Color fundus image; Davis DR grading: 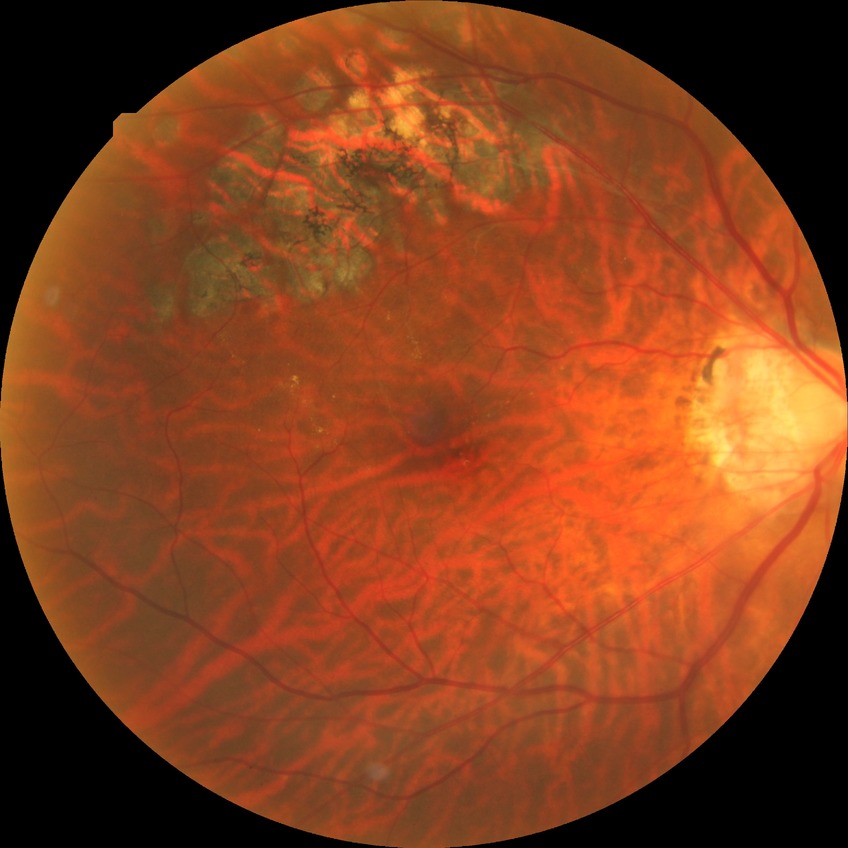

DR grade is NDR. No signs of diabetic retinopathy.